Fundus photo · 45-degree field of view
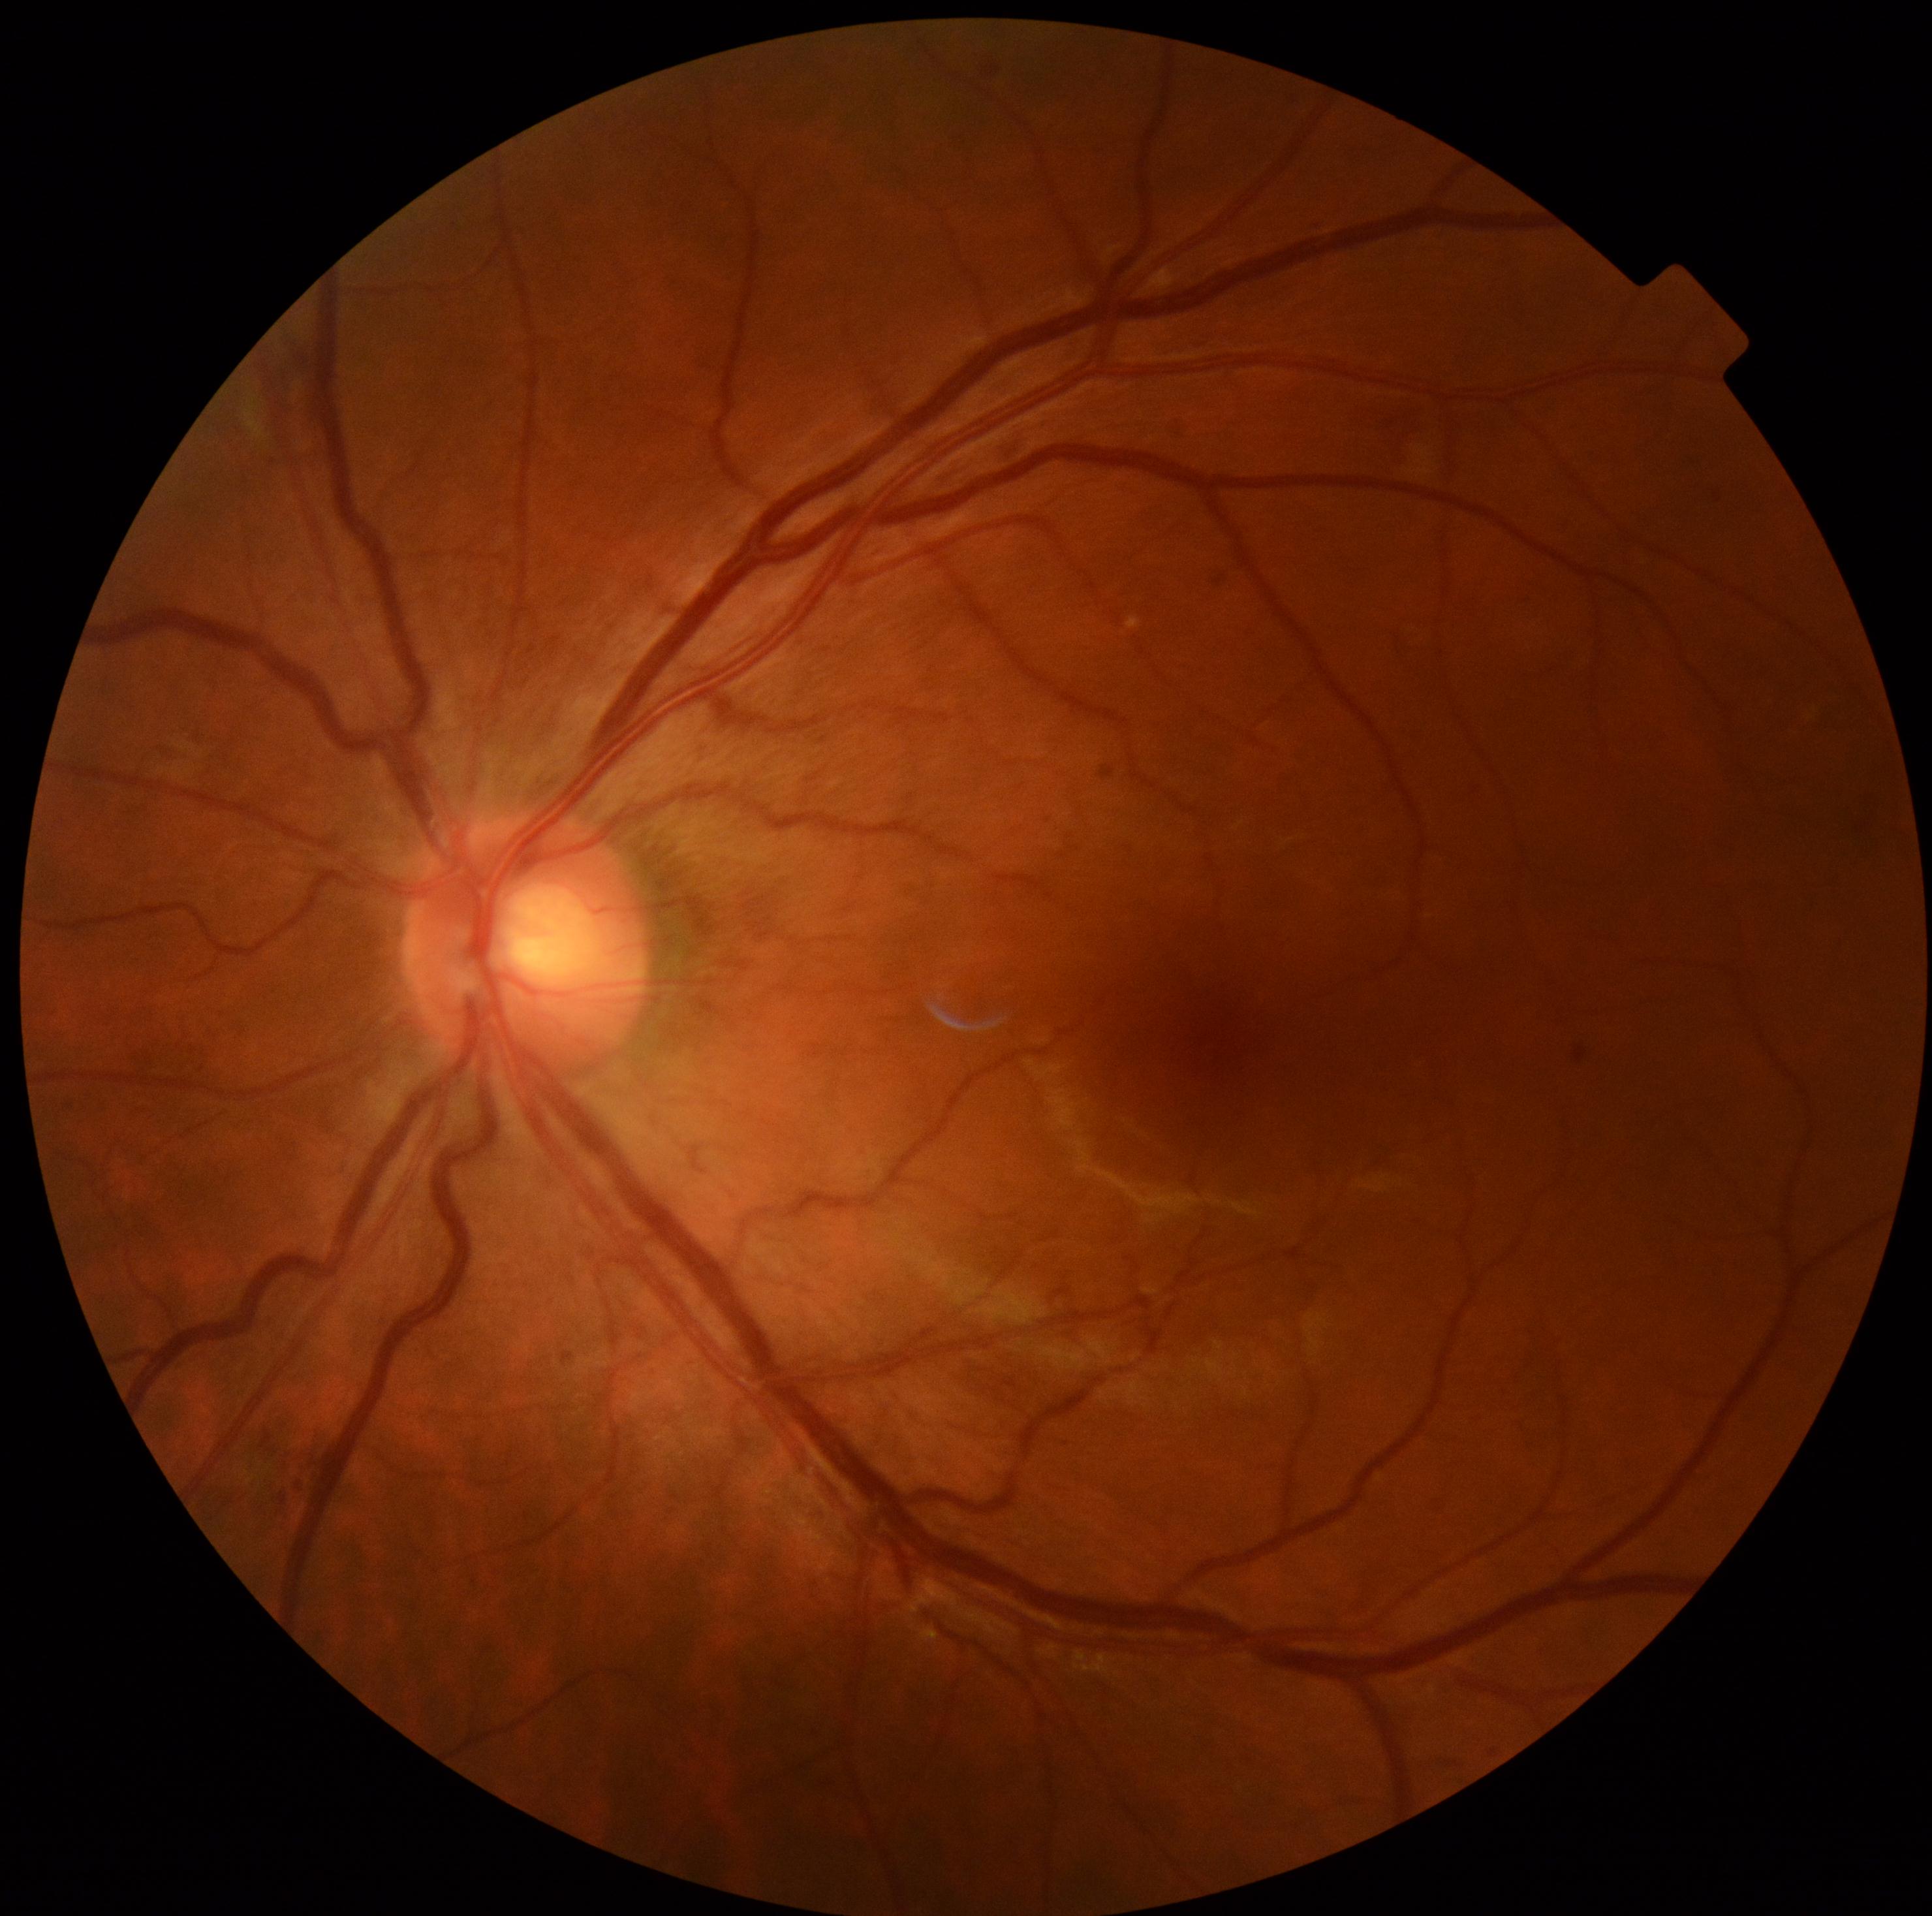

Retinopathy grade: mild NPDR (1).